1440 by 1080 pixels. Captured with the Natus RetCam Envision (130° field of view). Wide-field fundus photograph from neonatal ROP screening:
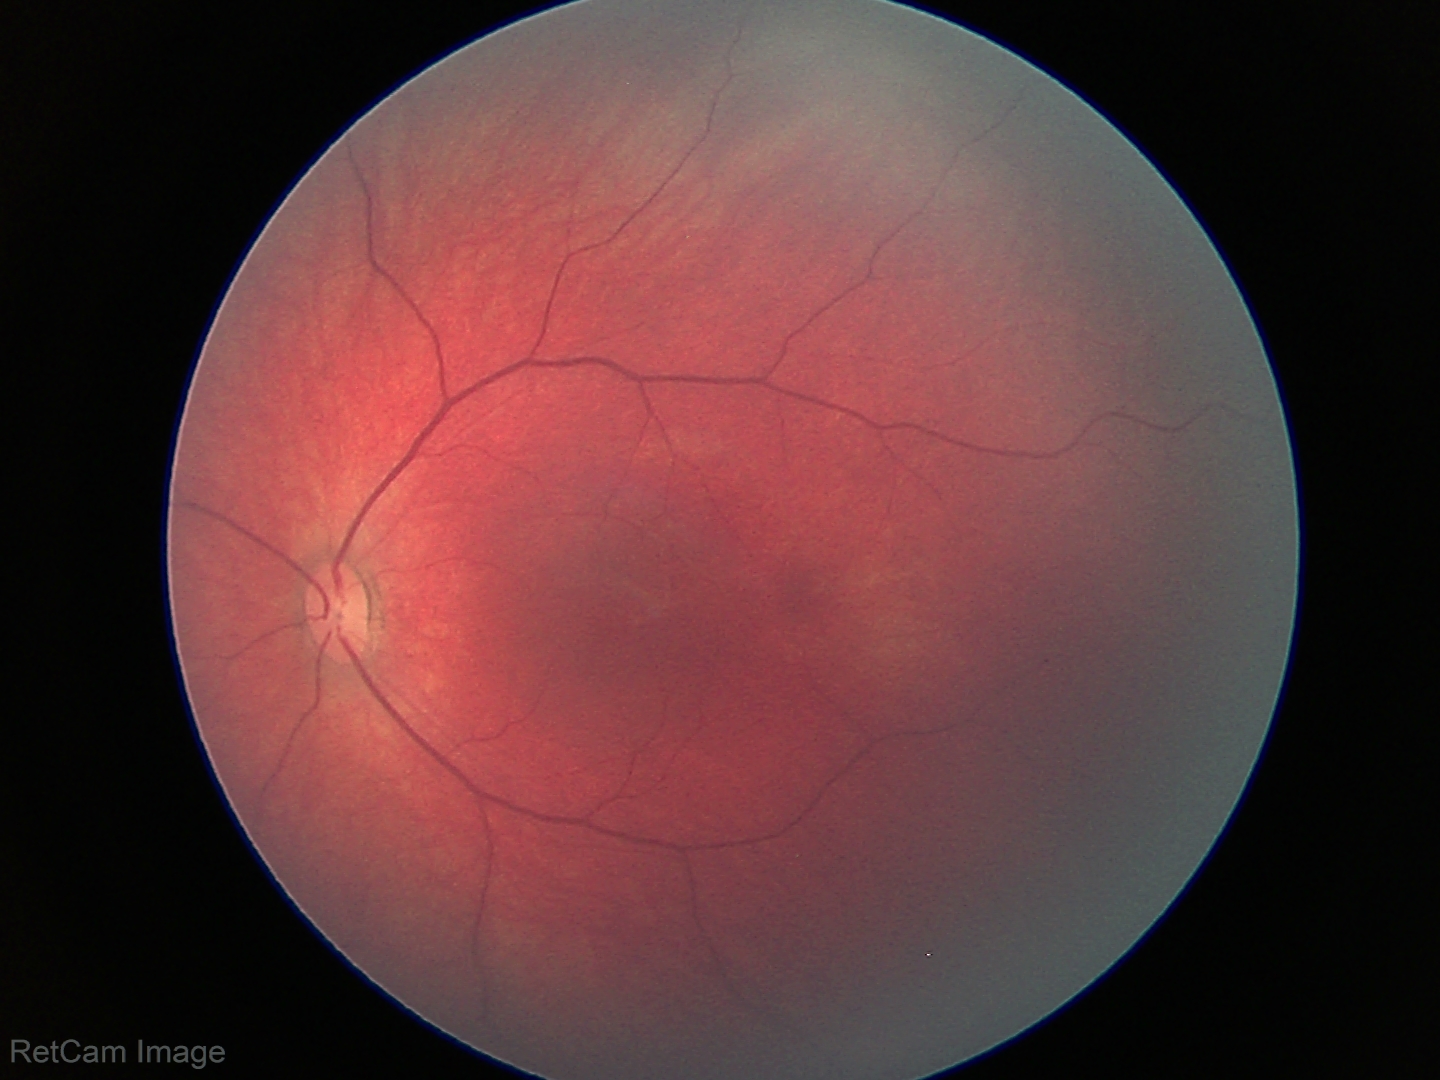 Impression: physiological appearance.